Pediatric retinal photograph (wide-field); 640x480px:
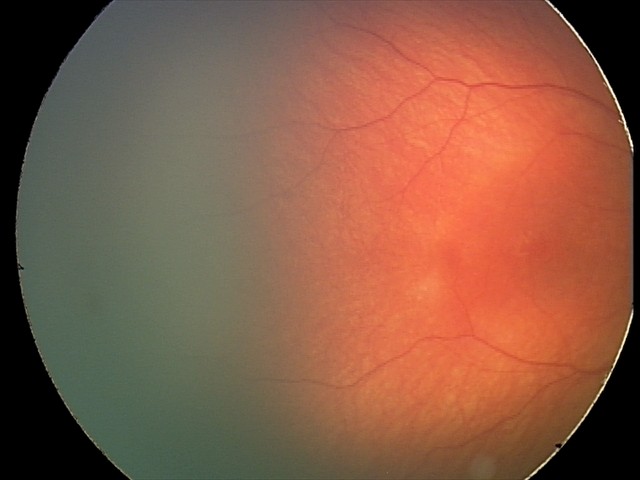
Screening examination with no abnormal retinal findings.